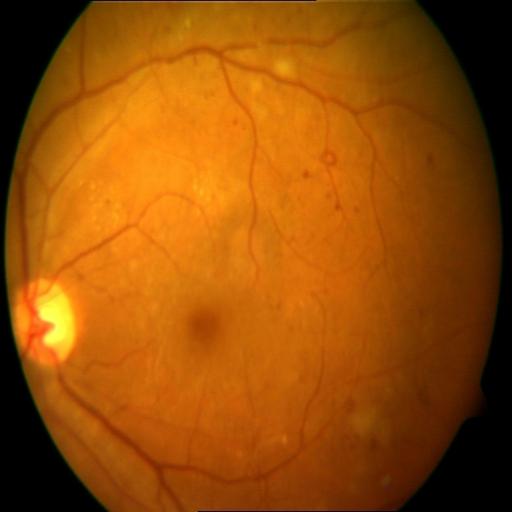 Diagnoses:
- HR (hemorrhagic retinopathy)
- CWS (cotton wool spots)